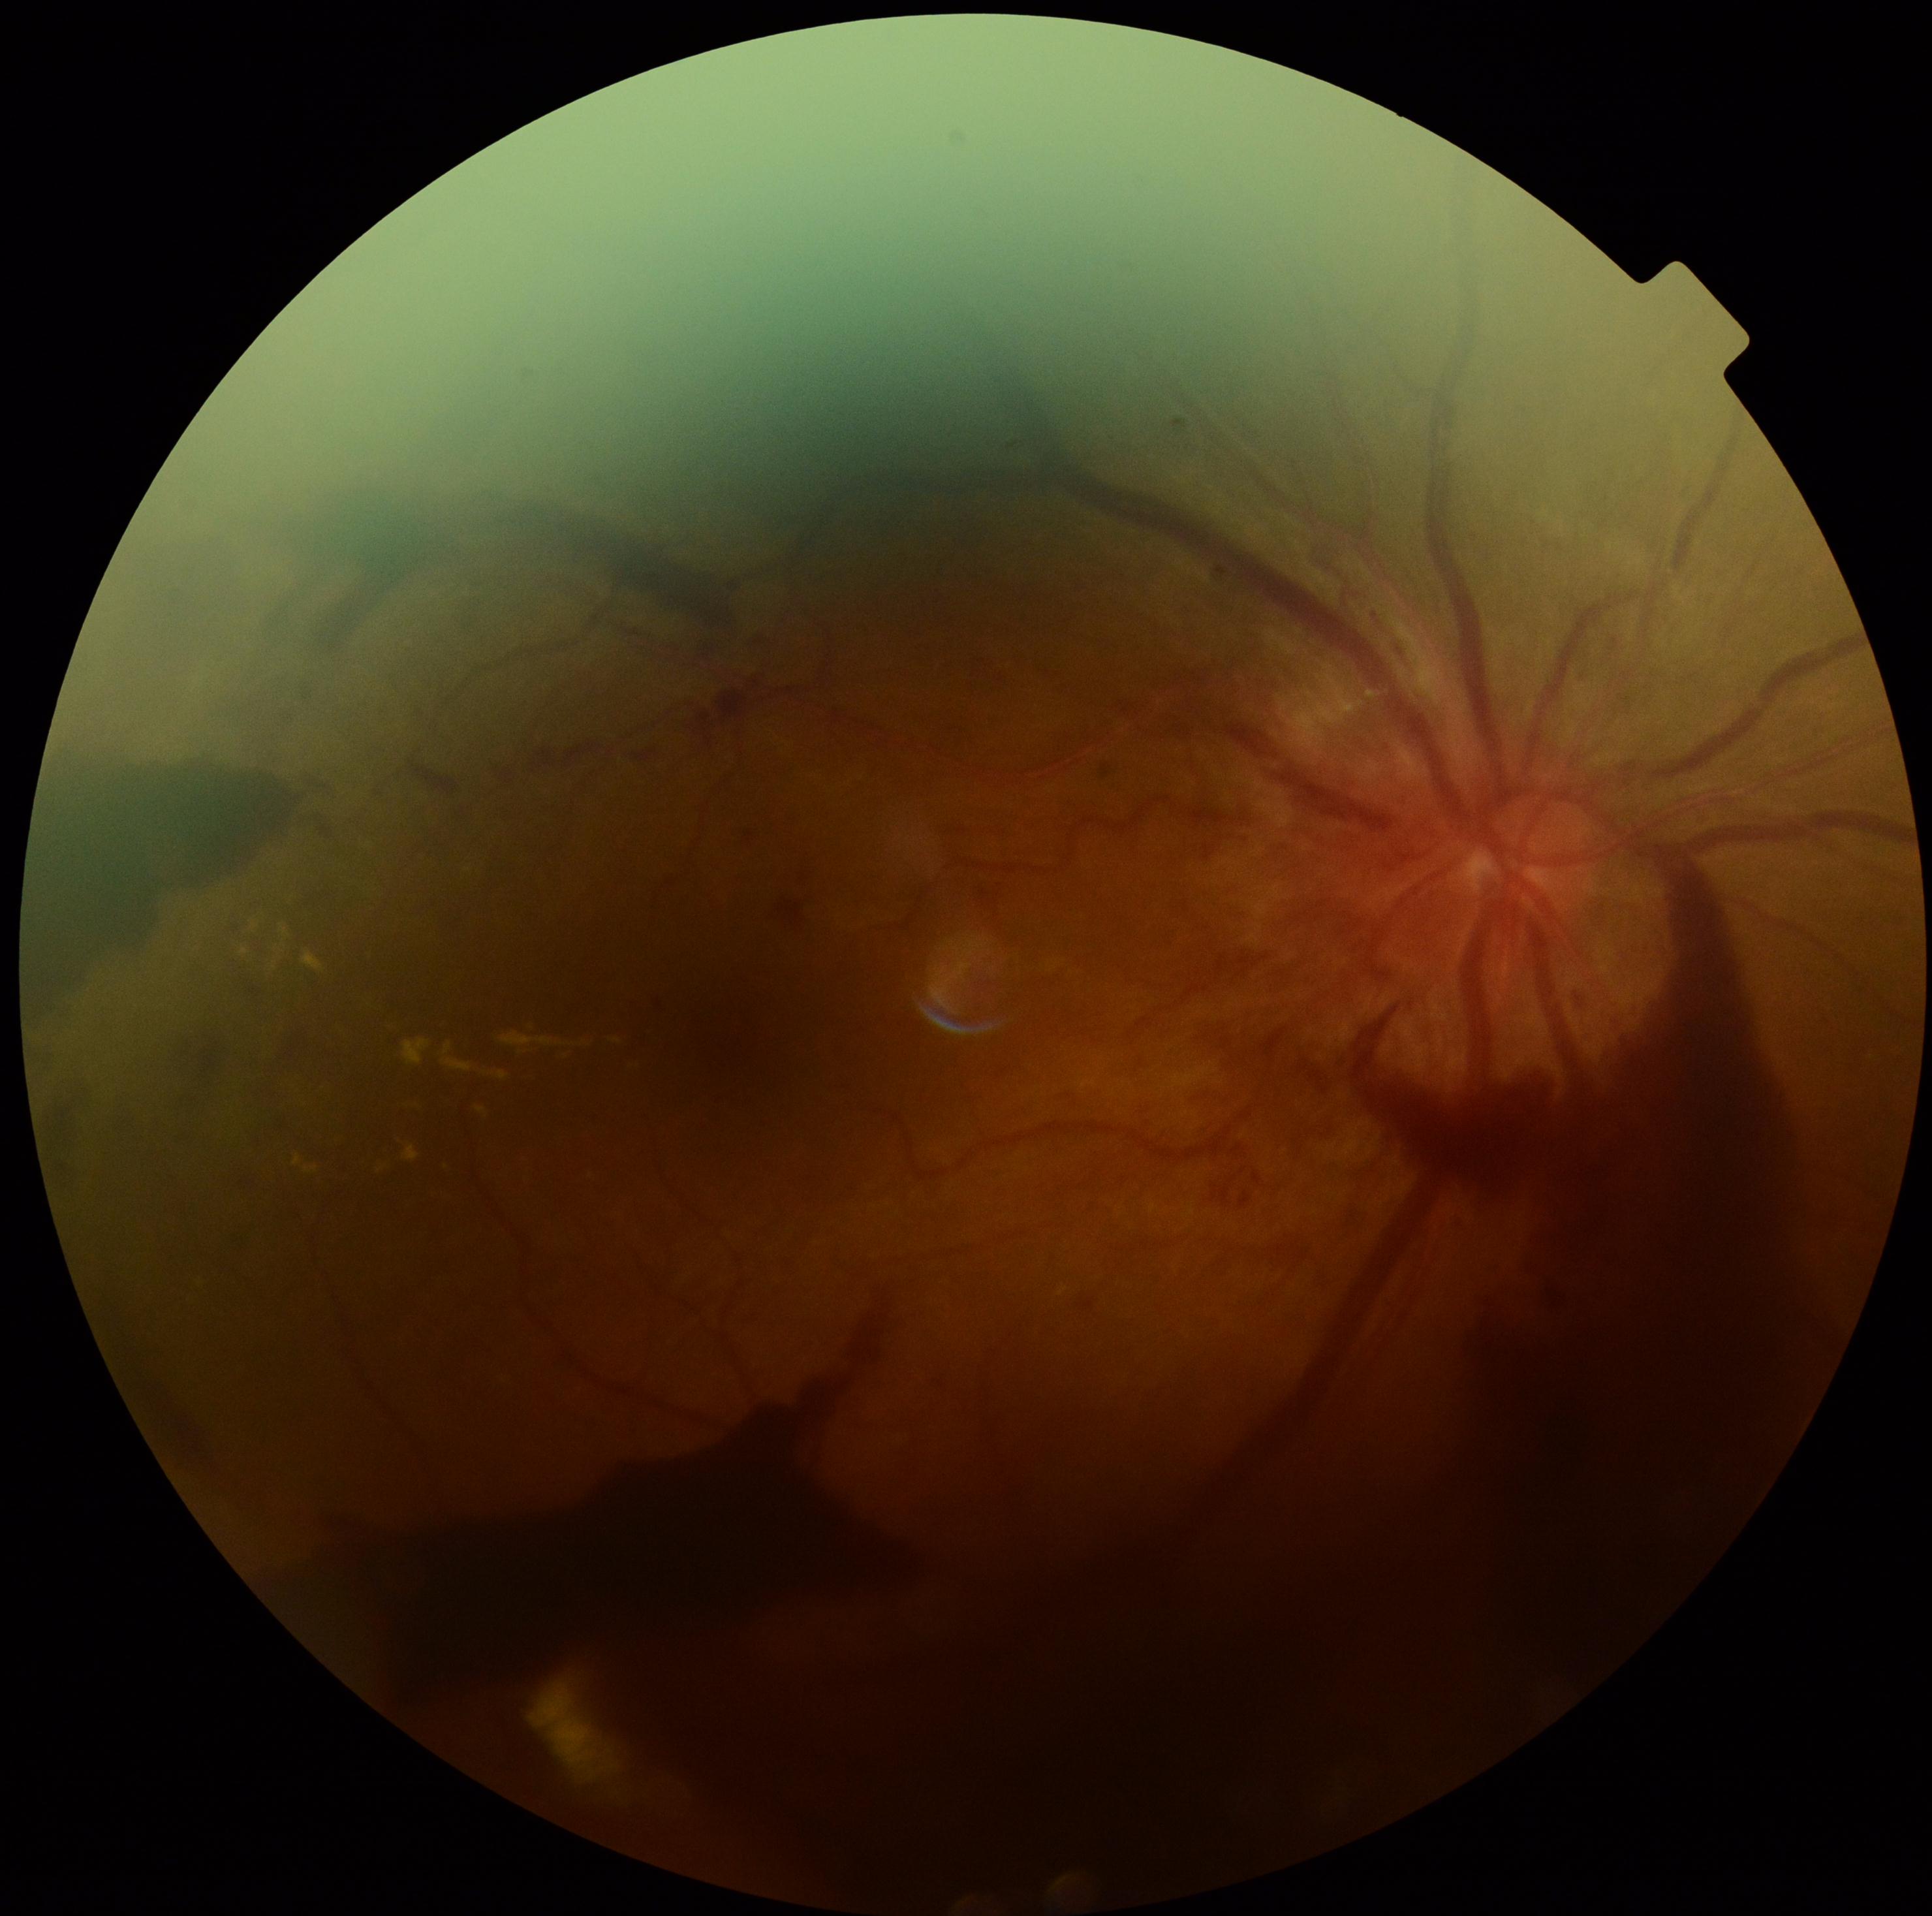
diabetic retinopathy grade: PDR (4) — neovascularization and/or vitreous/pre-retinal hemorrhage, DR class: proliferative diabetic retinopathy.